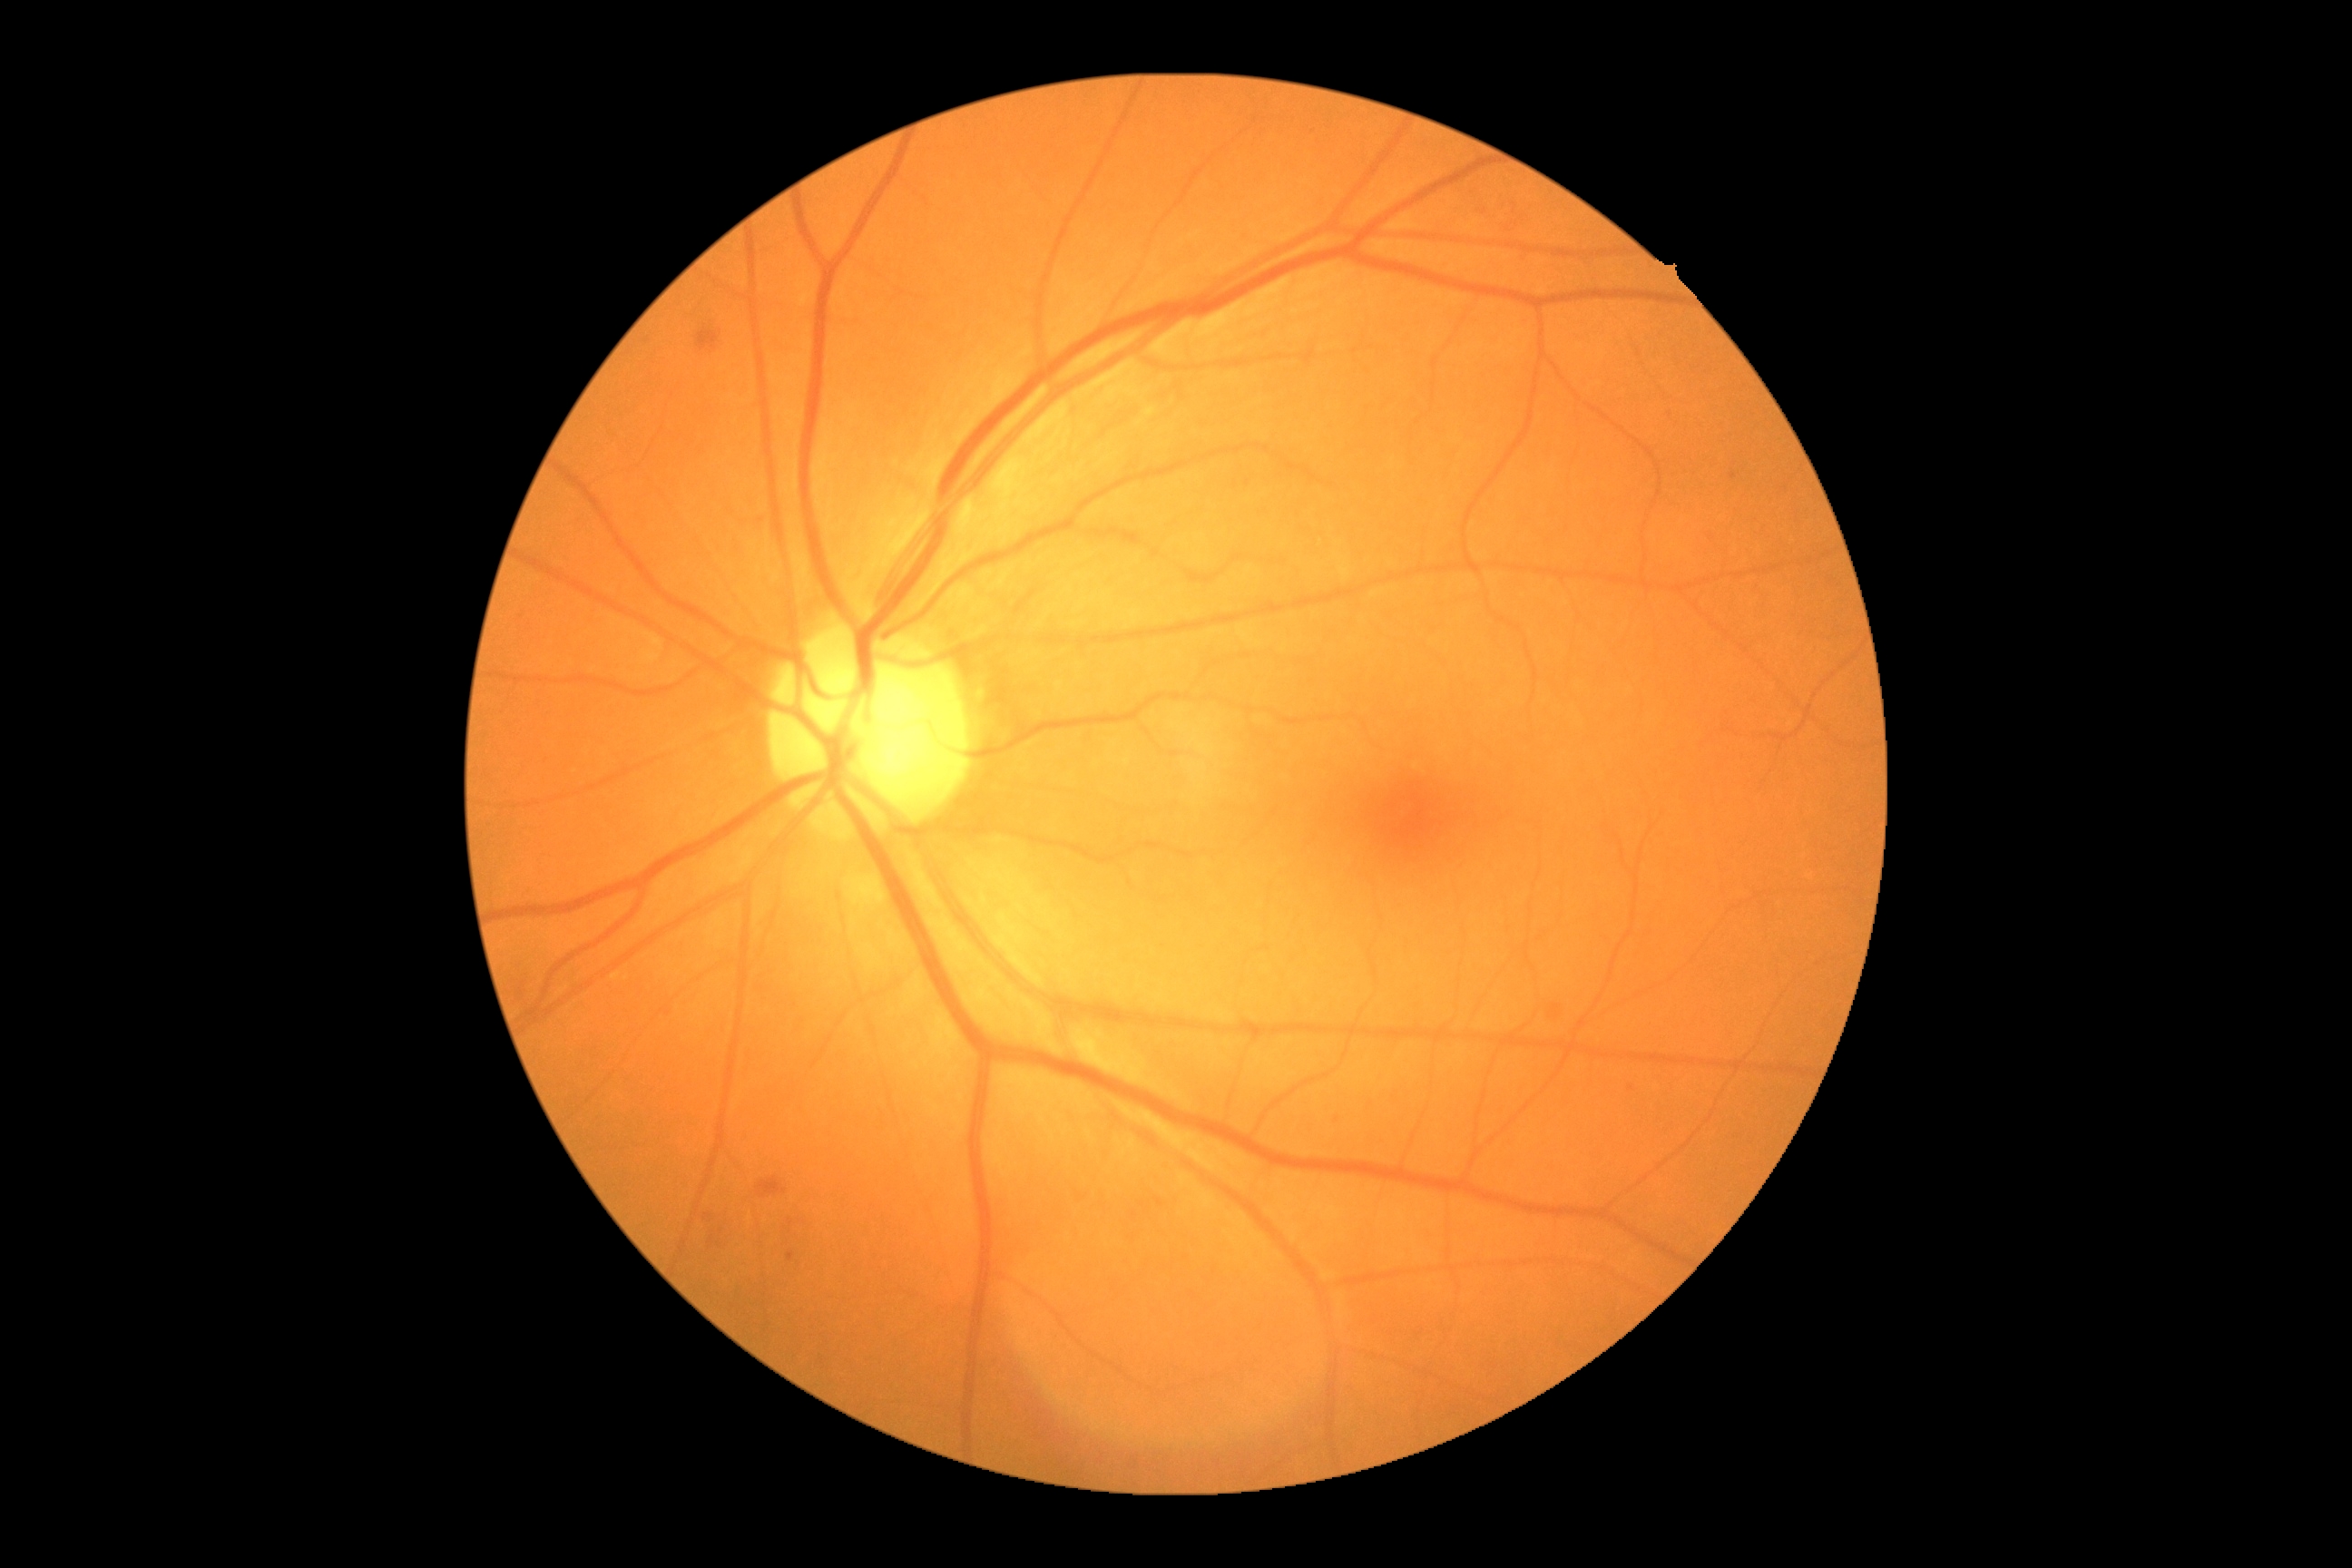   dr_grade: 2